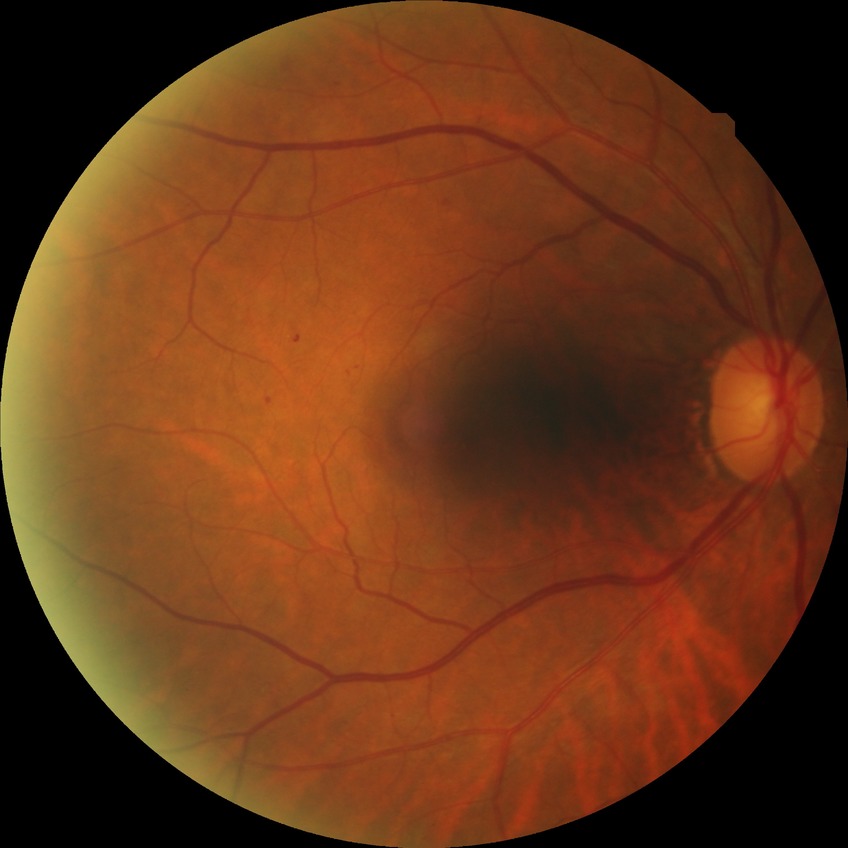
DR grade: SDR.